Image size 2212x1659:
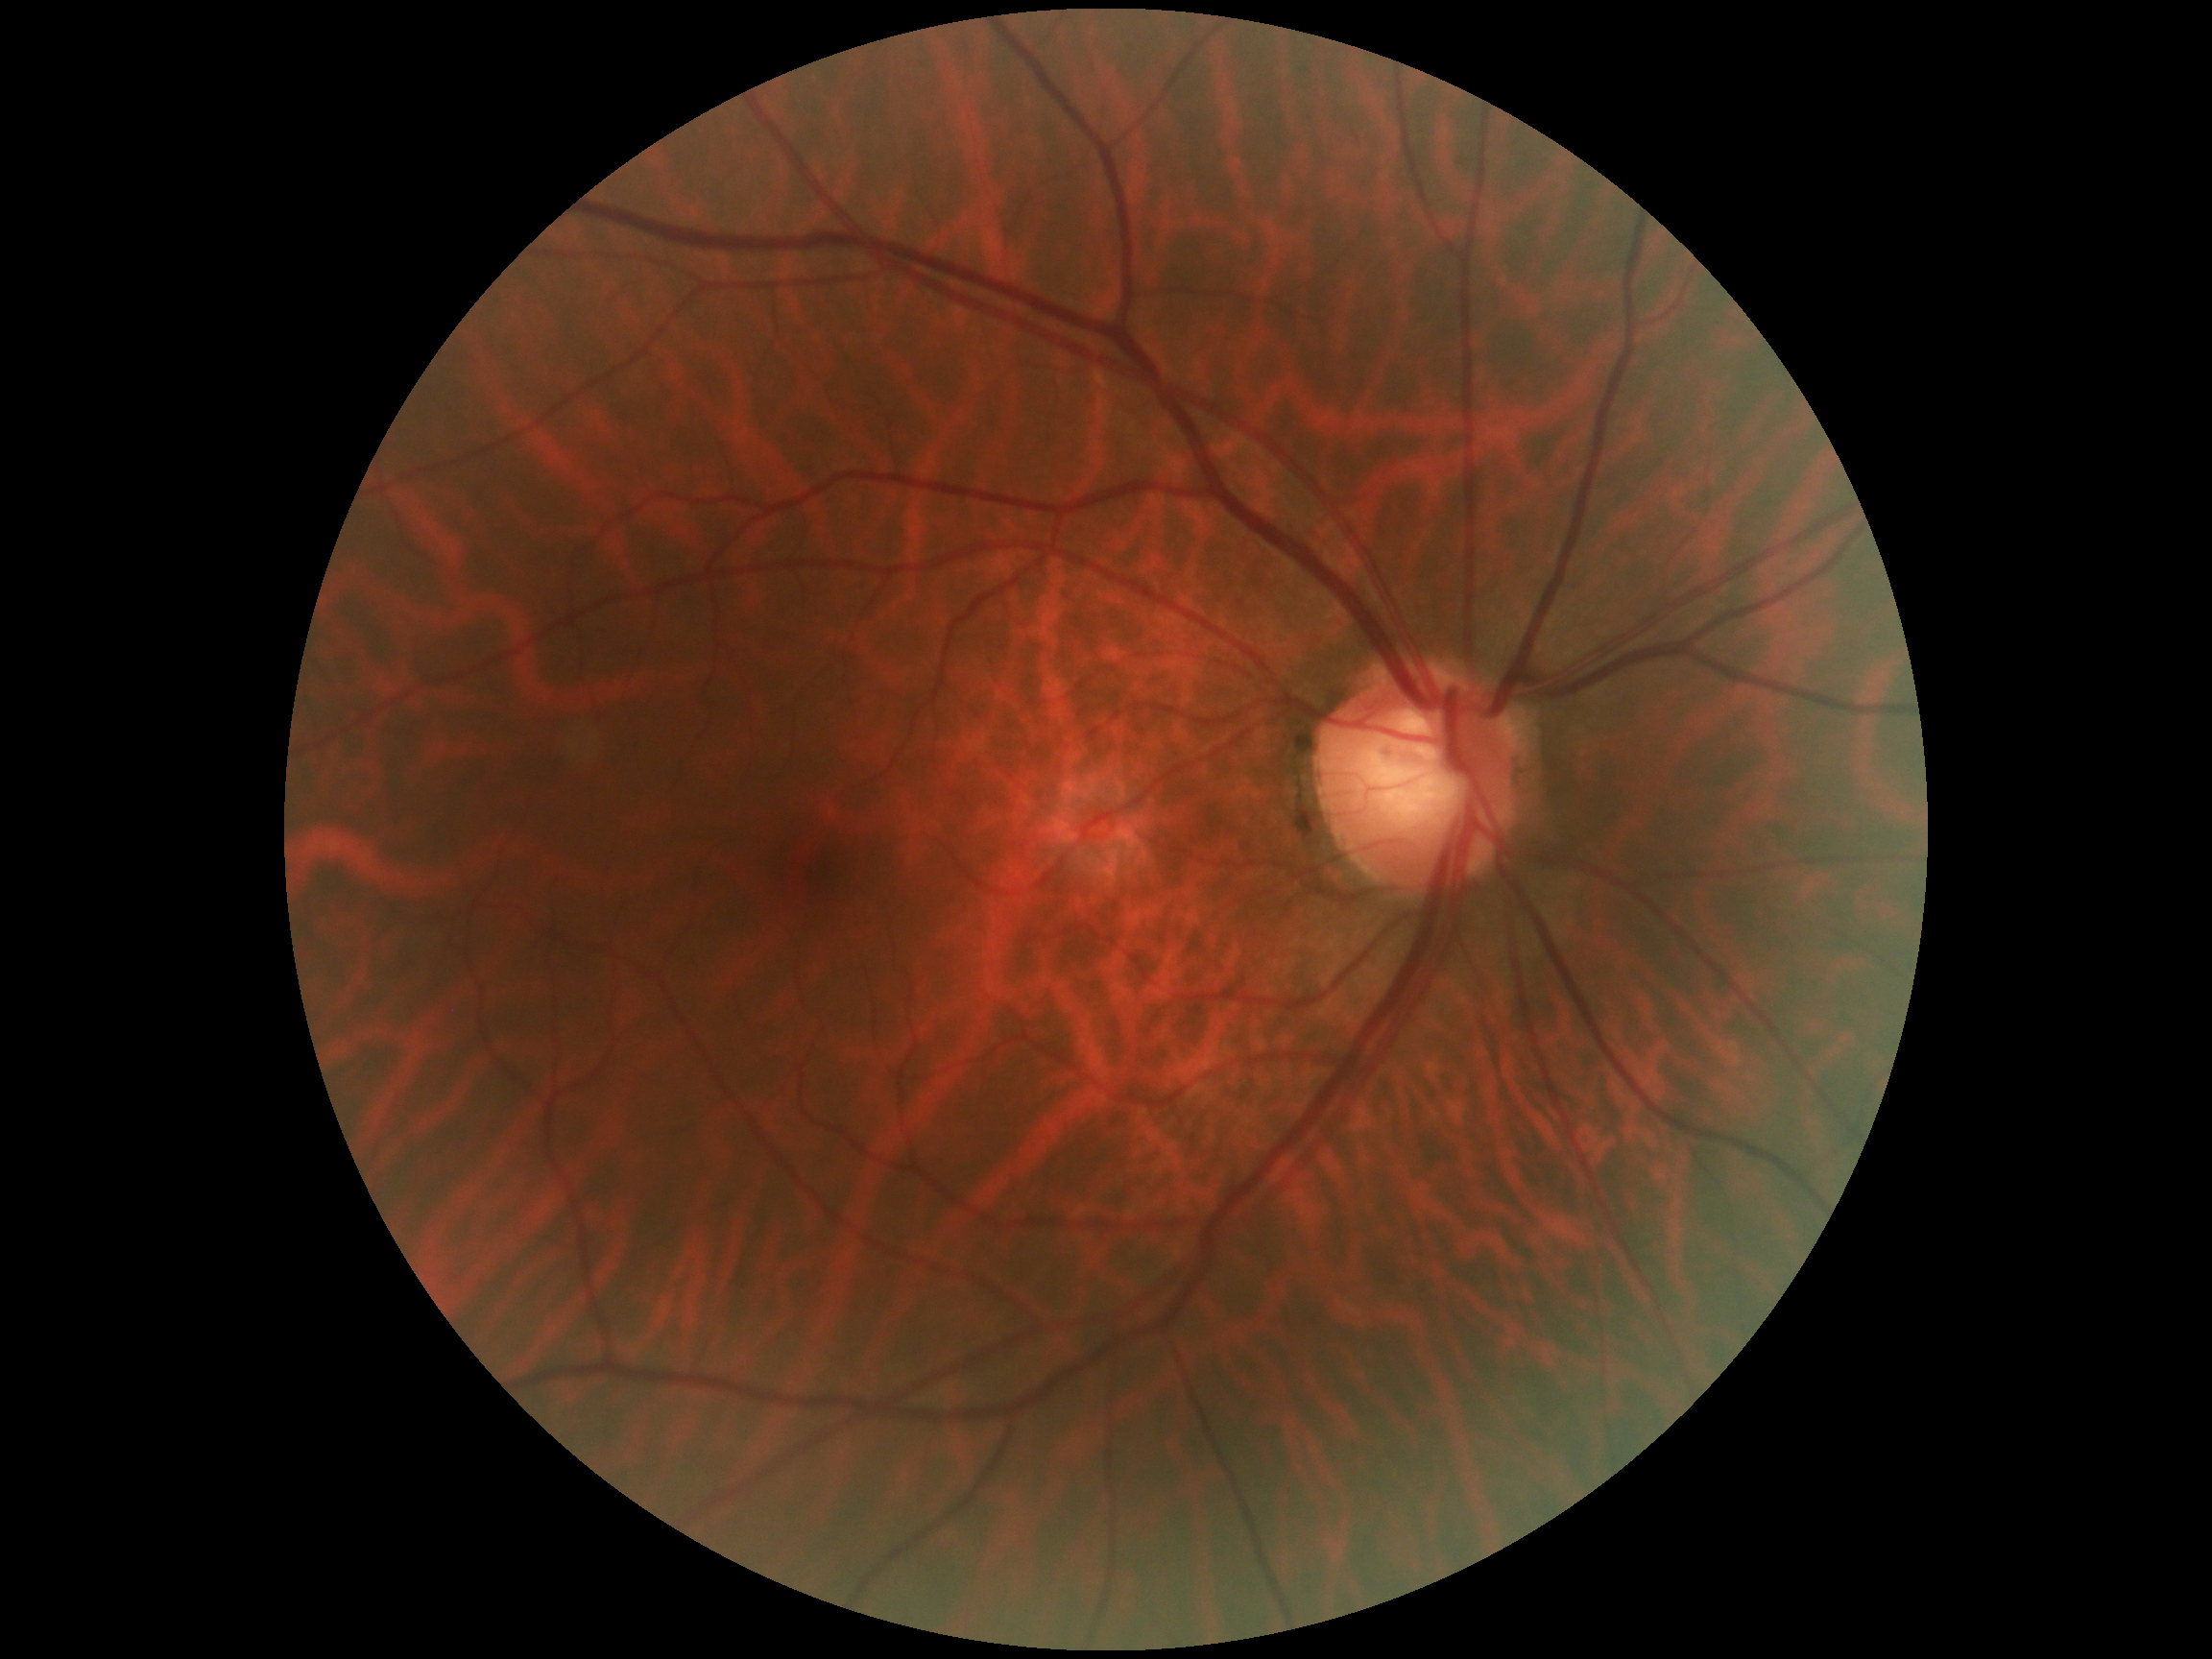

DR grade is no apparent retinopathy (0).
No DR findings.